Pediatric wide-field fundus photograph — 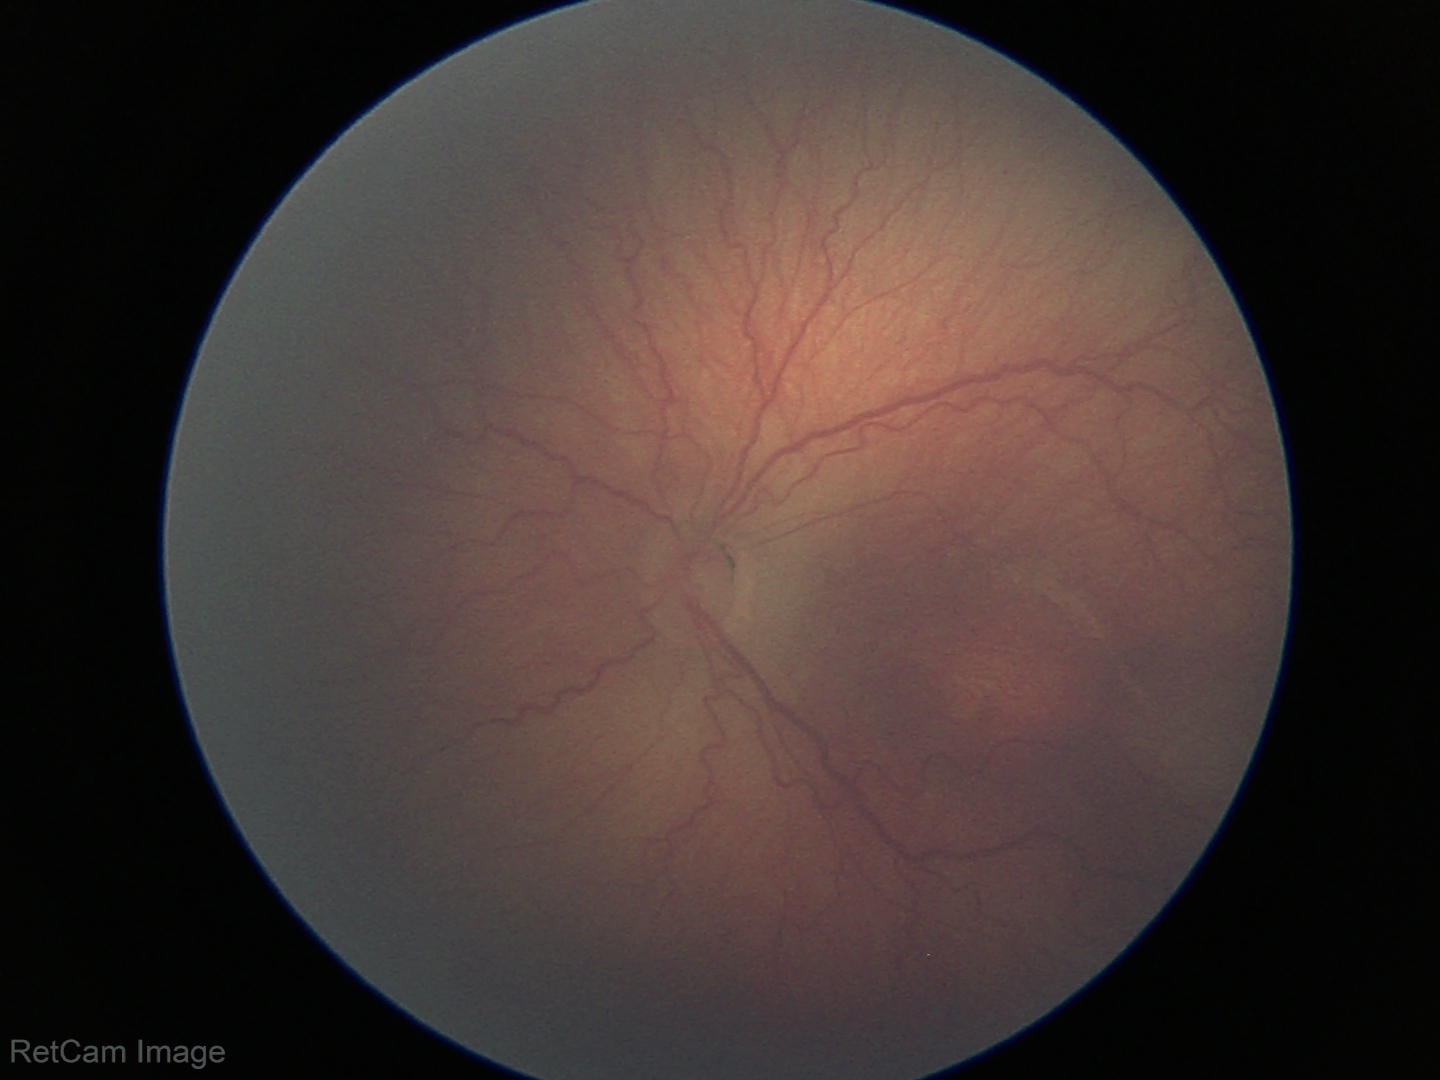

From an examination with diagnosis of ROP stage 2 — ridge with height and width at the demarcation line. Without plus disease.